Color fundus image
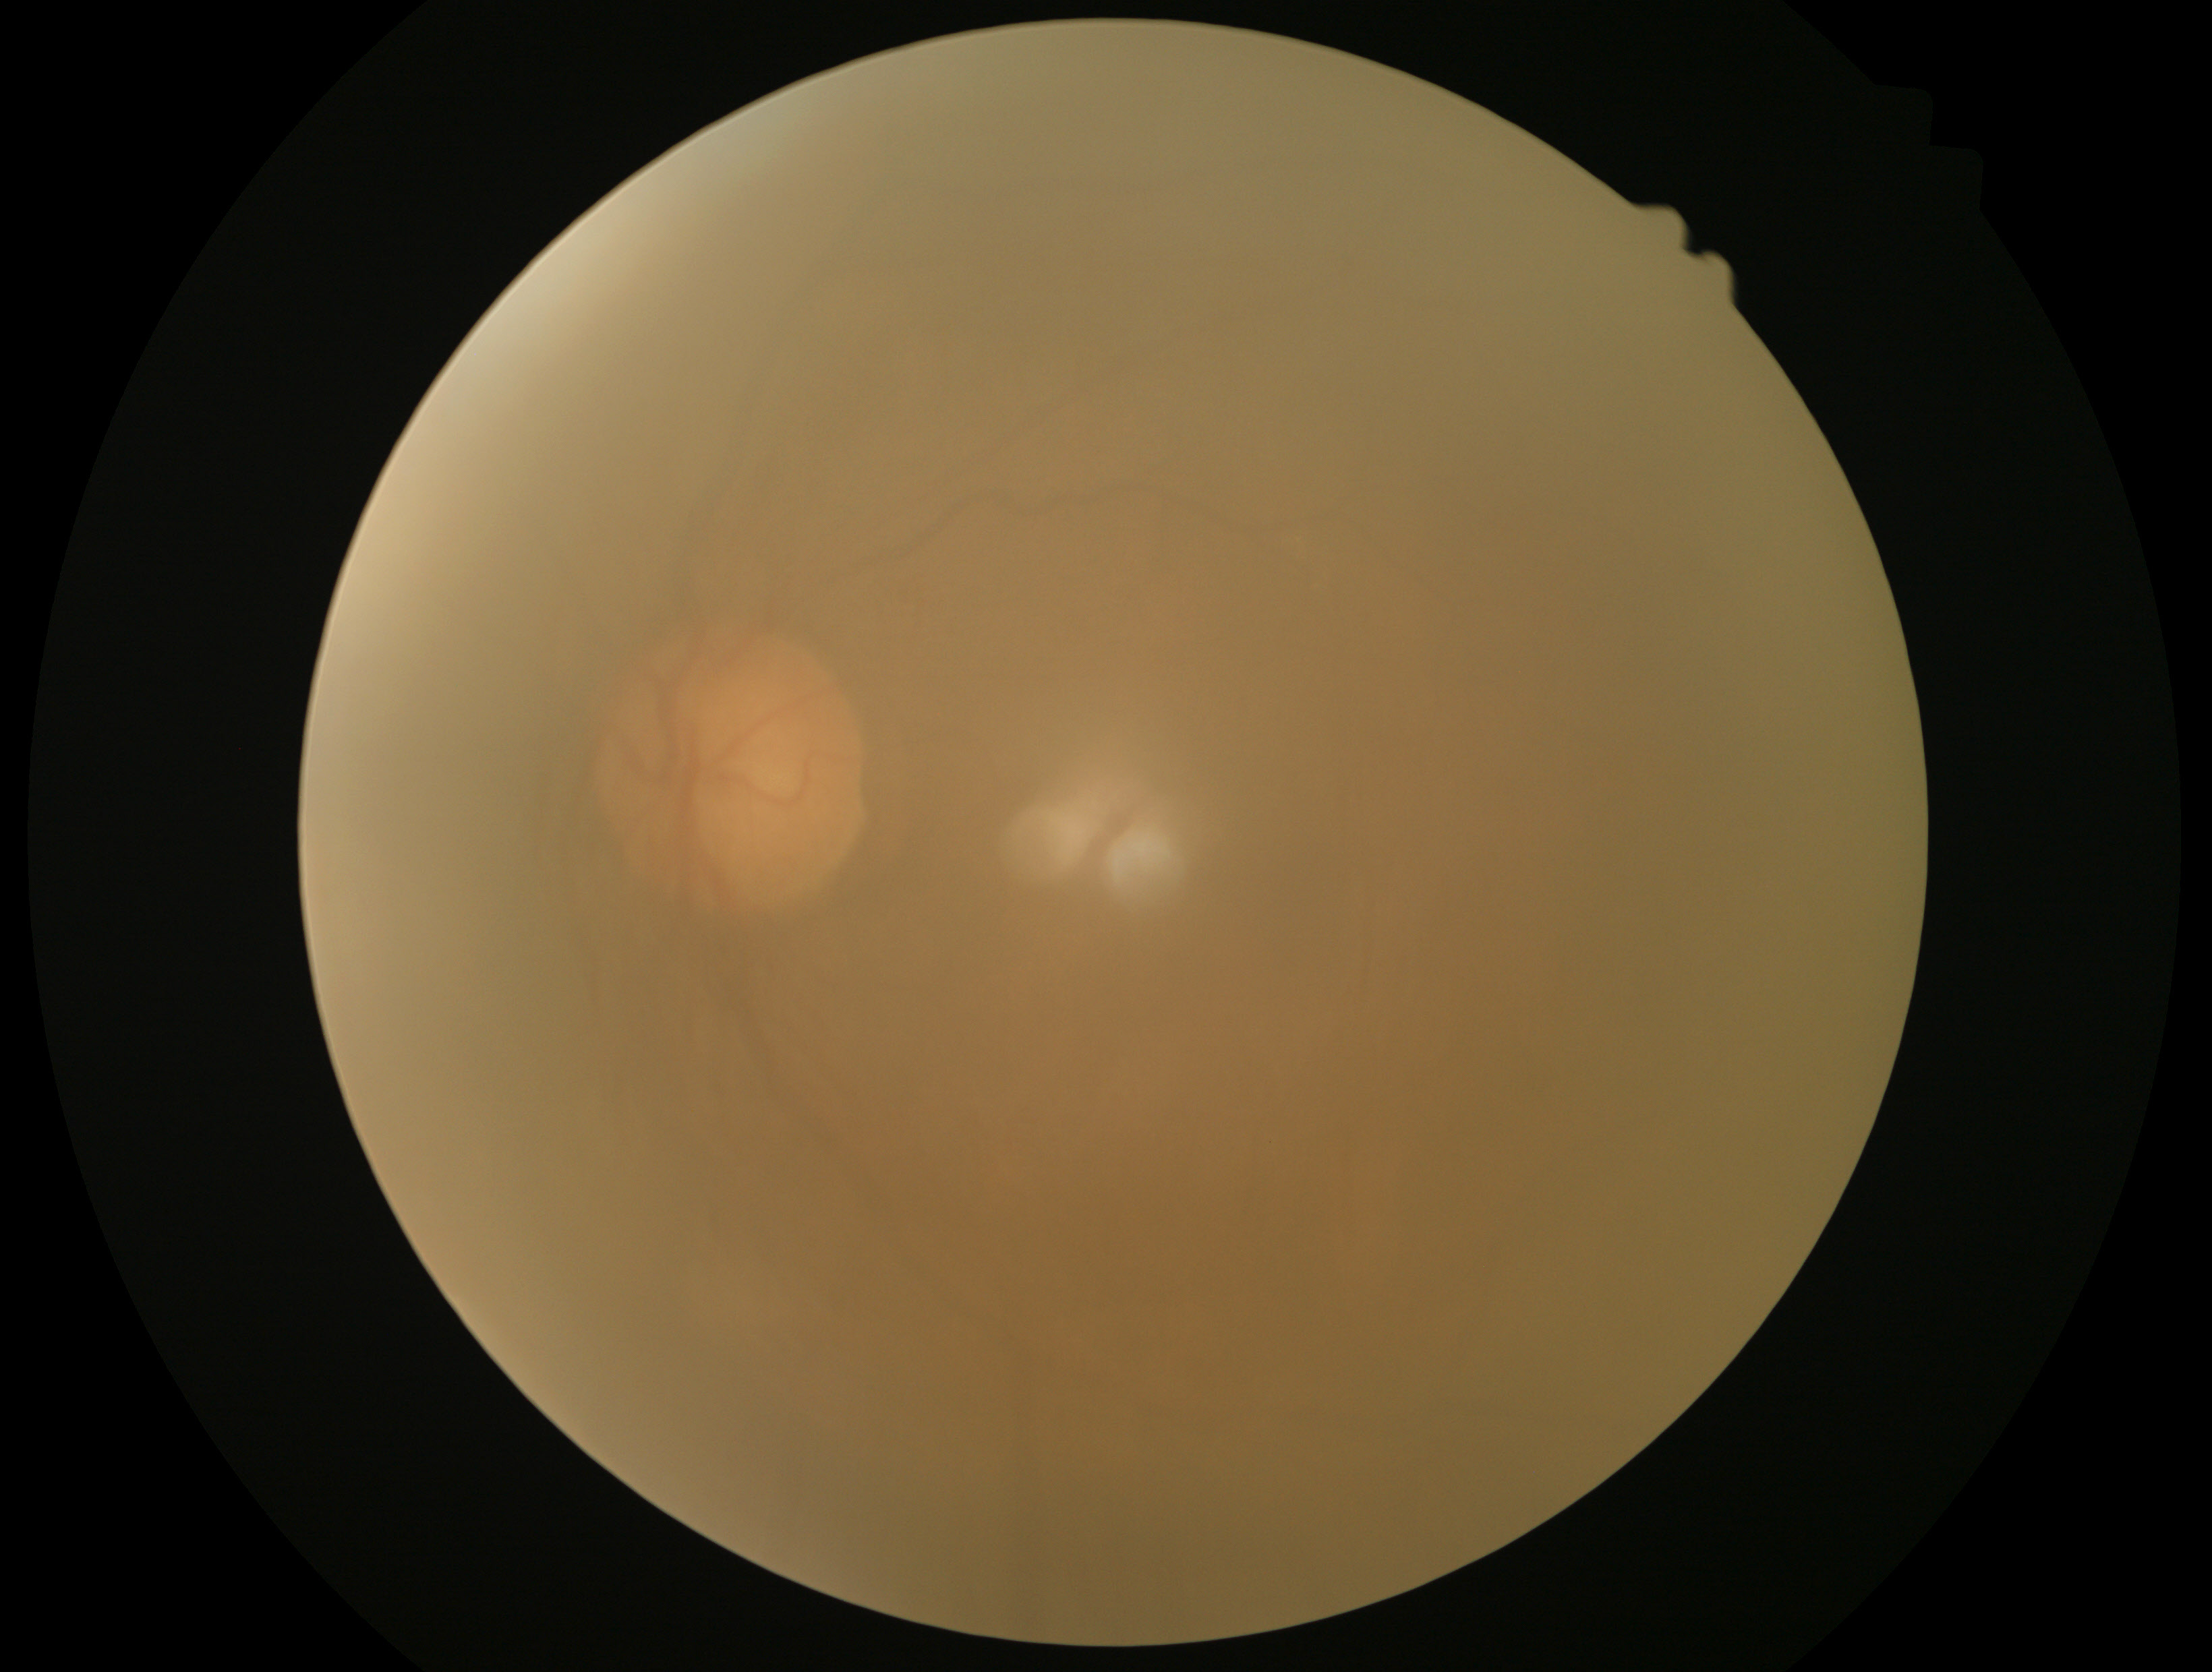 quality: below grading threshold
dr_grade: ungradable due to poor image quality